45° FOV, 1725x1721, CFP:
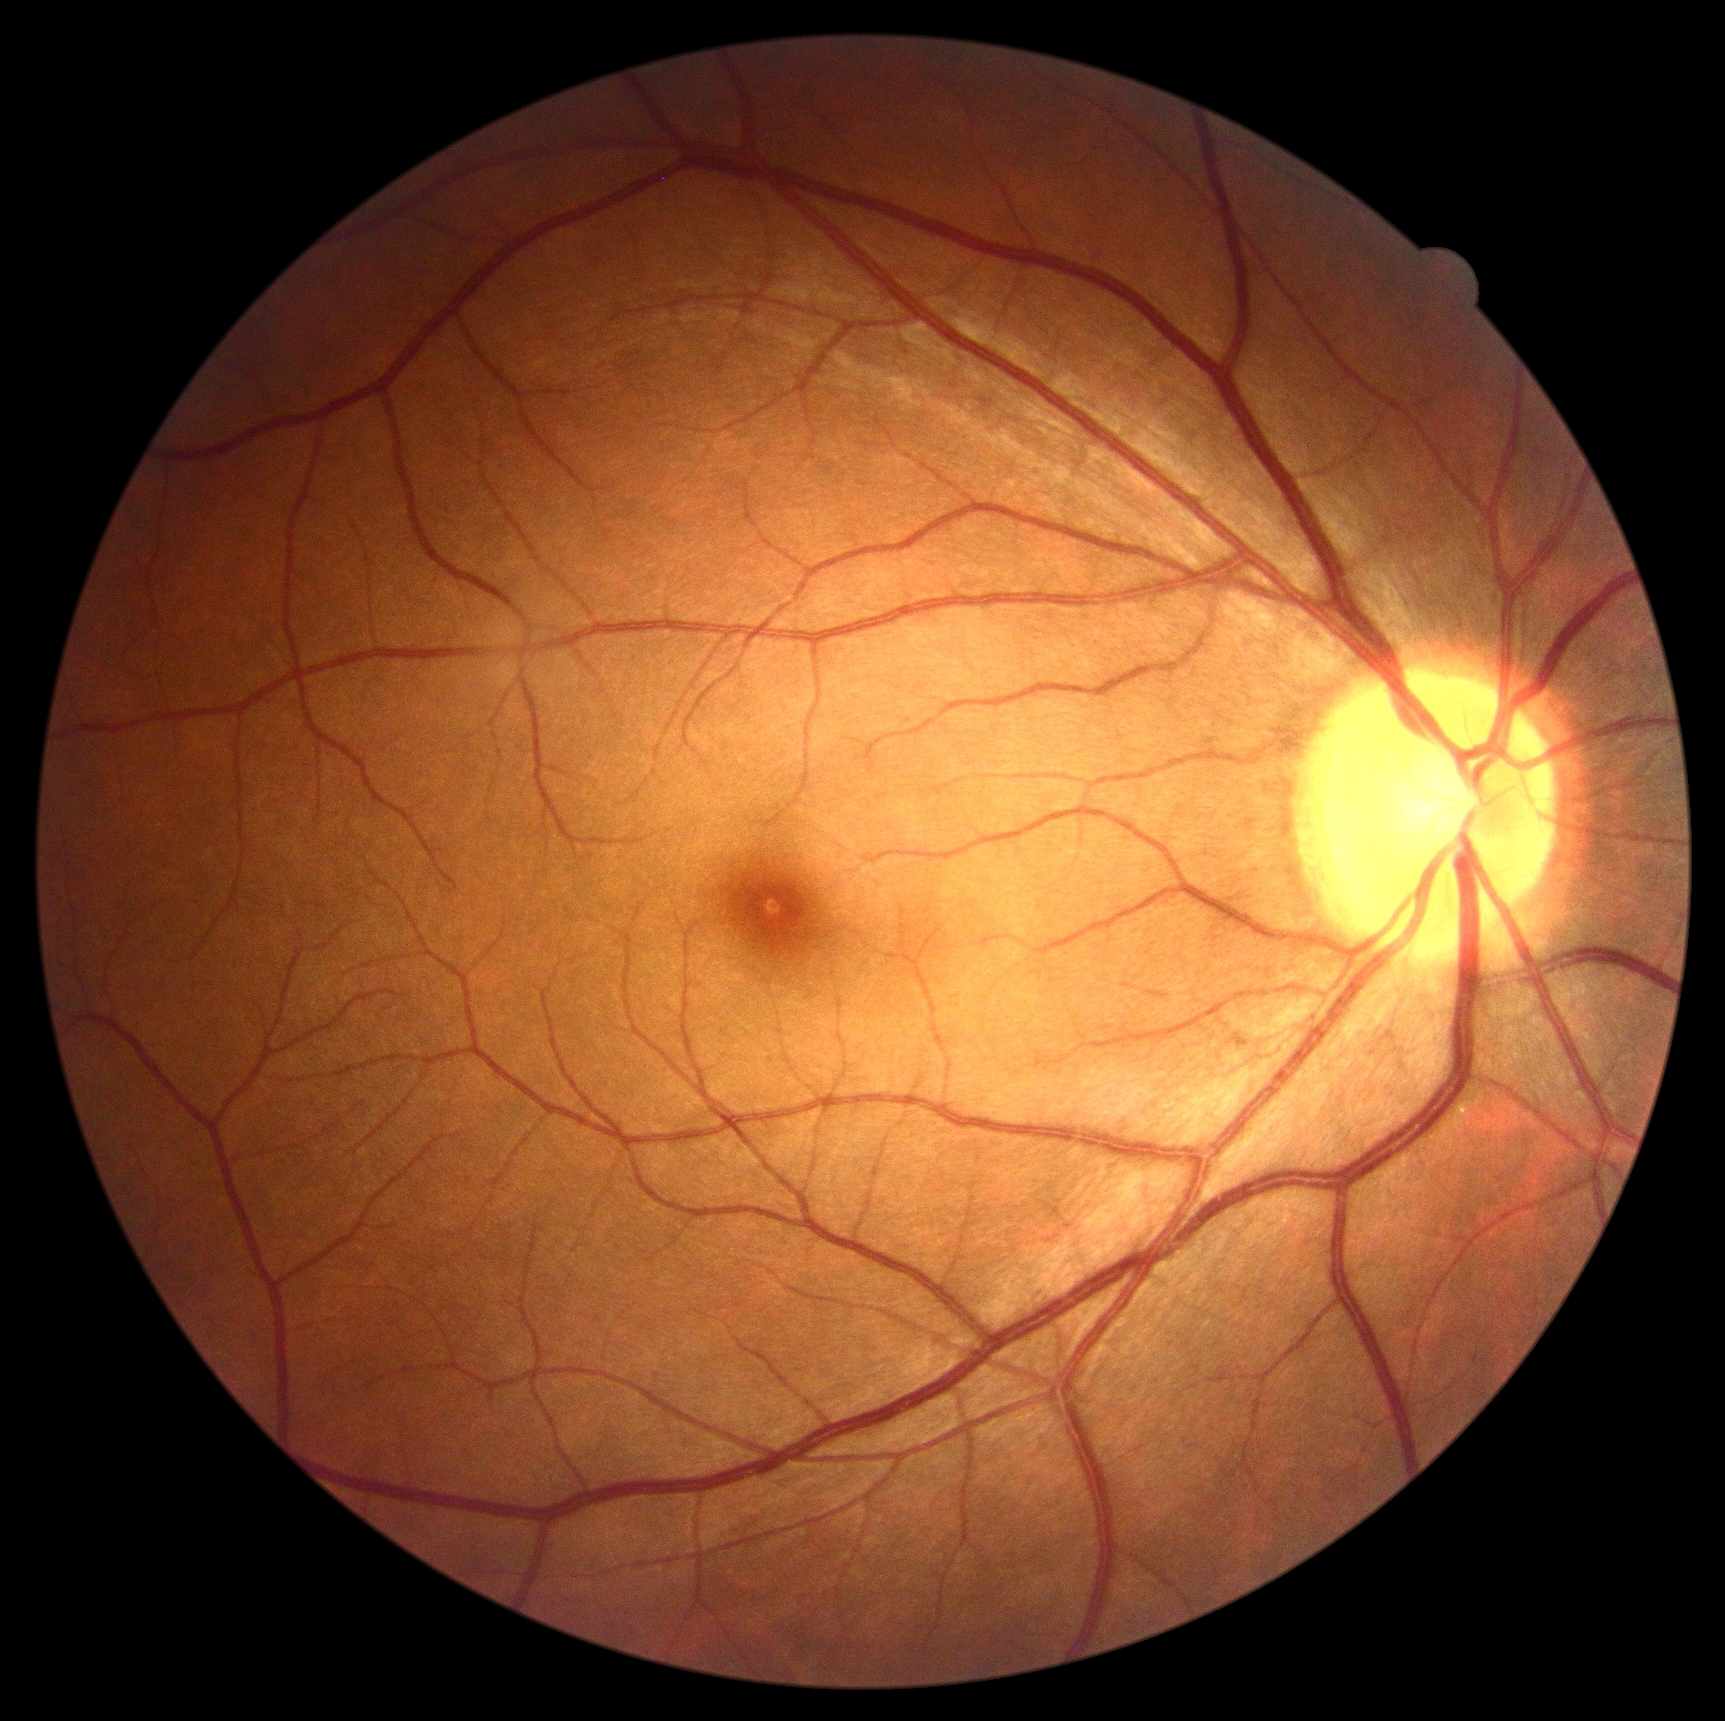
DR stage is no apparent diabetic retinopathy (grade 0). No diabetic retinal disease findings.